Captured with pupil dilation, FOV 35° before cropping, optic disc region of a color fundus photo — 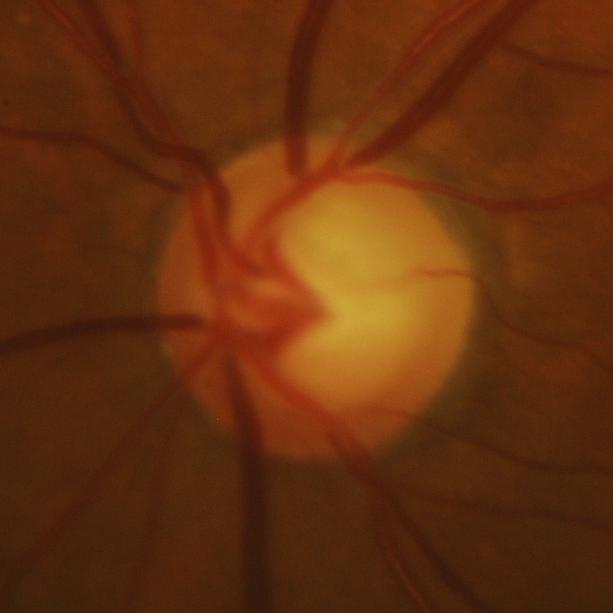
There is evidence of glaucomatous findings.